45-degree field of view — 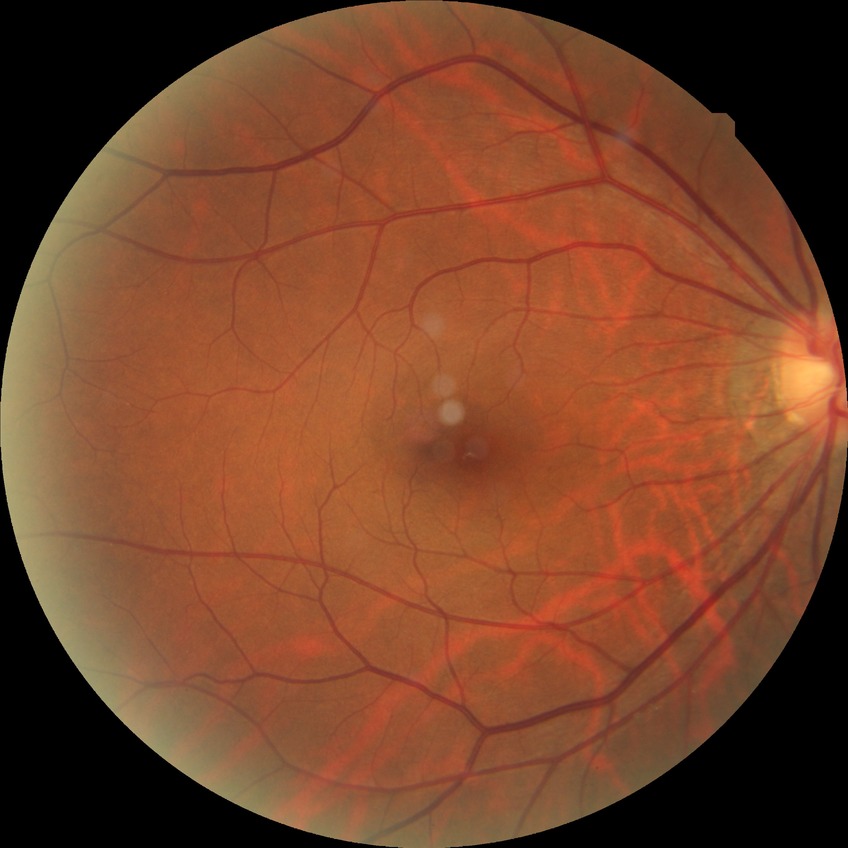 Disease class: non-proliferative diabetic retinopathy. Diabetic retinopathy (DR): SDR (simple diabetic retinopathy).